1240x1240; pediatric retinal photograph (wide-field).
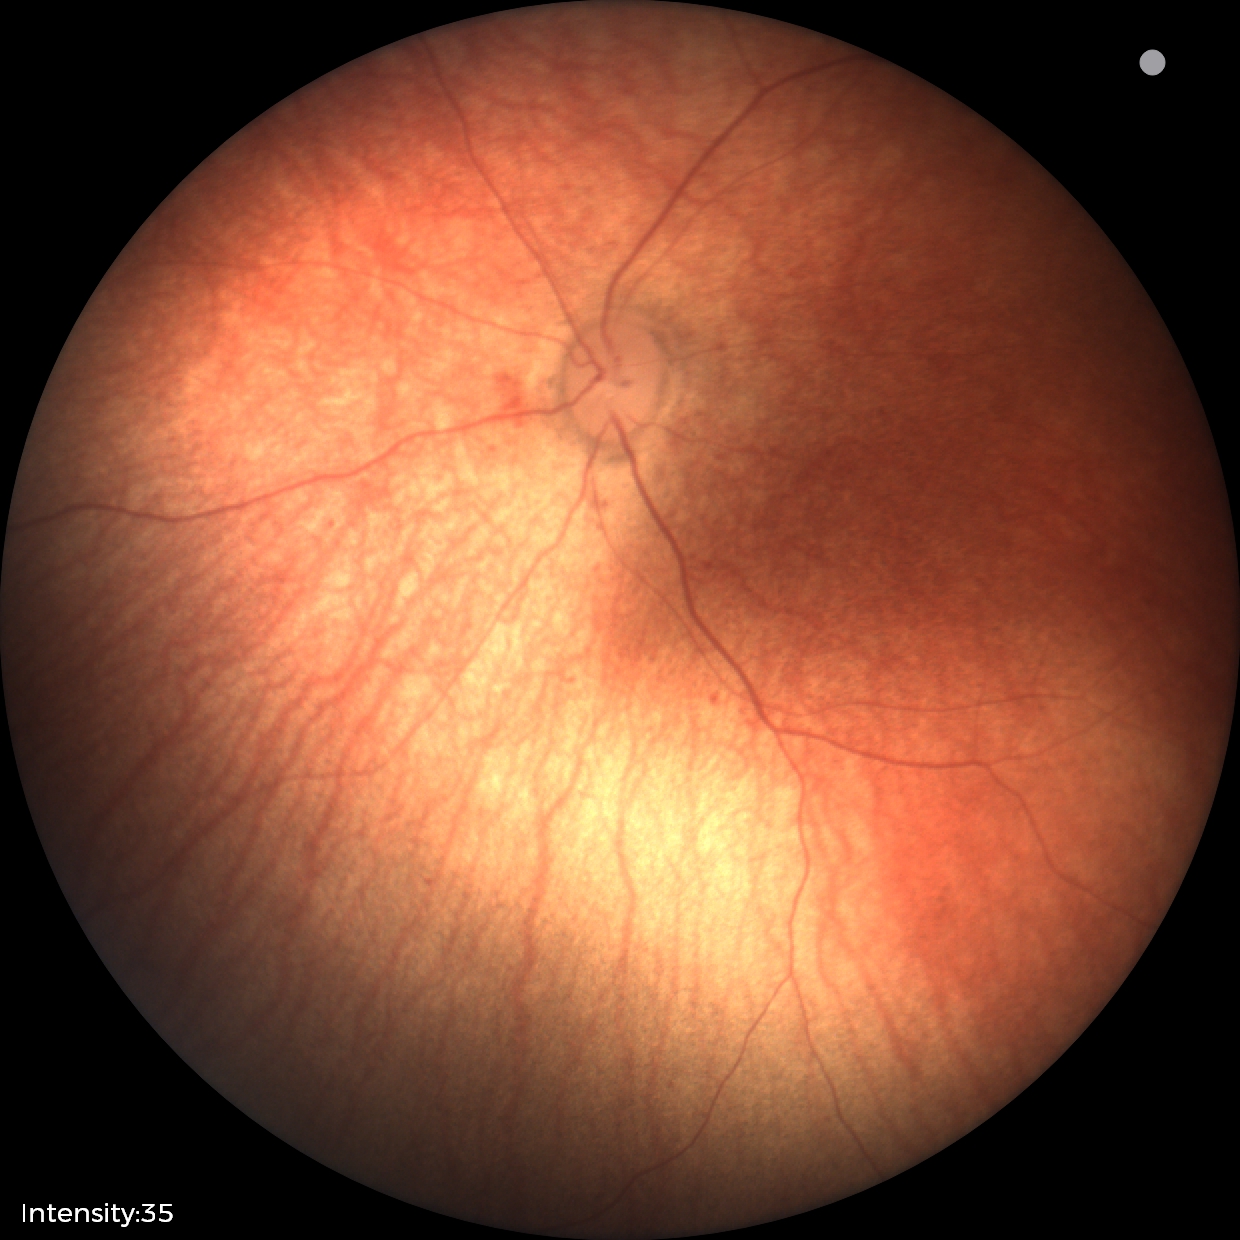

Screening examination diagnosed as physiological.